Male · color fundus photograph · Topcon TRC-NW400 · non-mydriatic acquisition · disc-centered field · IOP 14 mmHg · FOV: 30 degrees · 2212x1661px · refraction: +2.25 -2 × 80°.
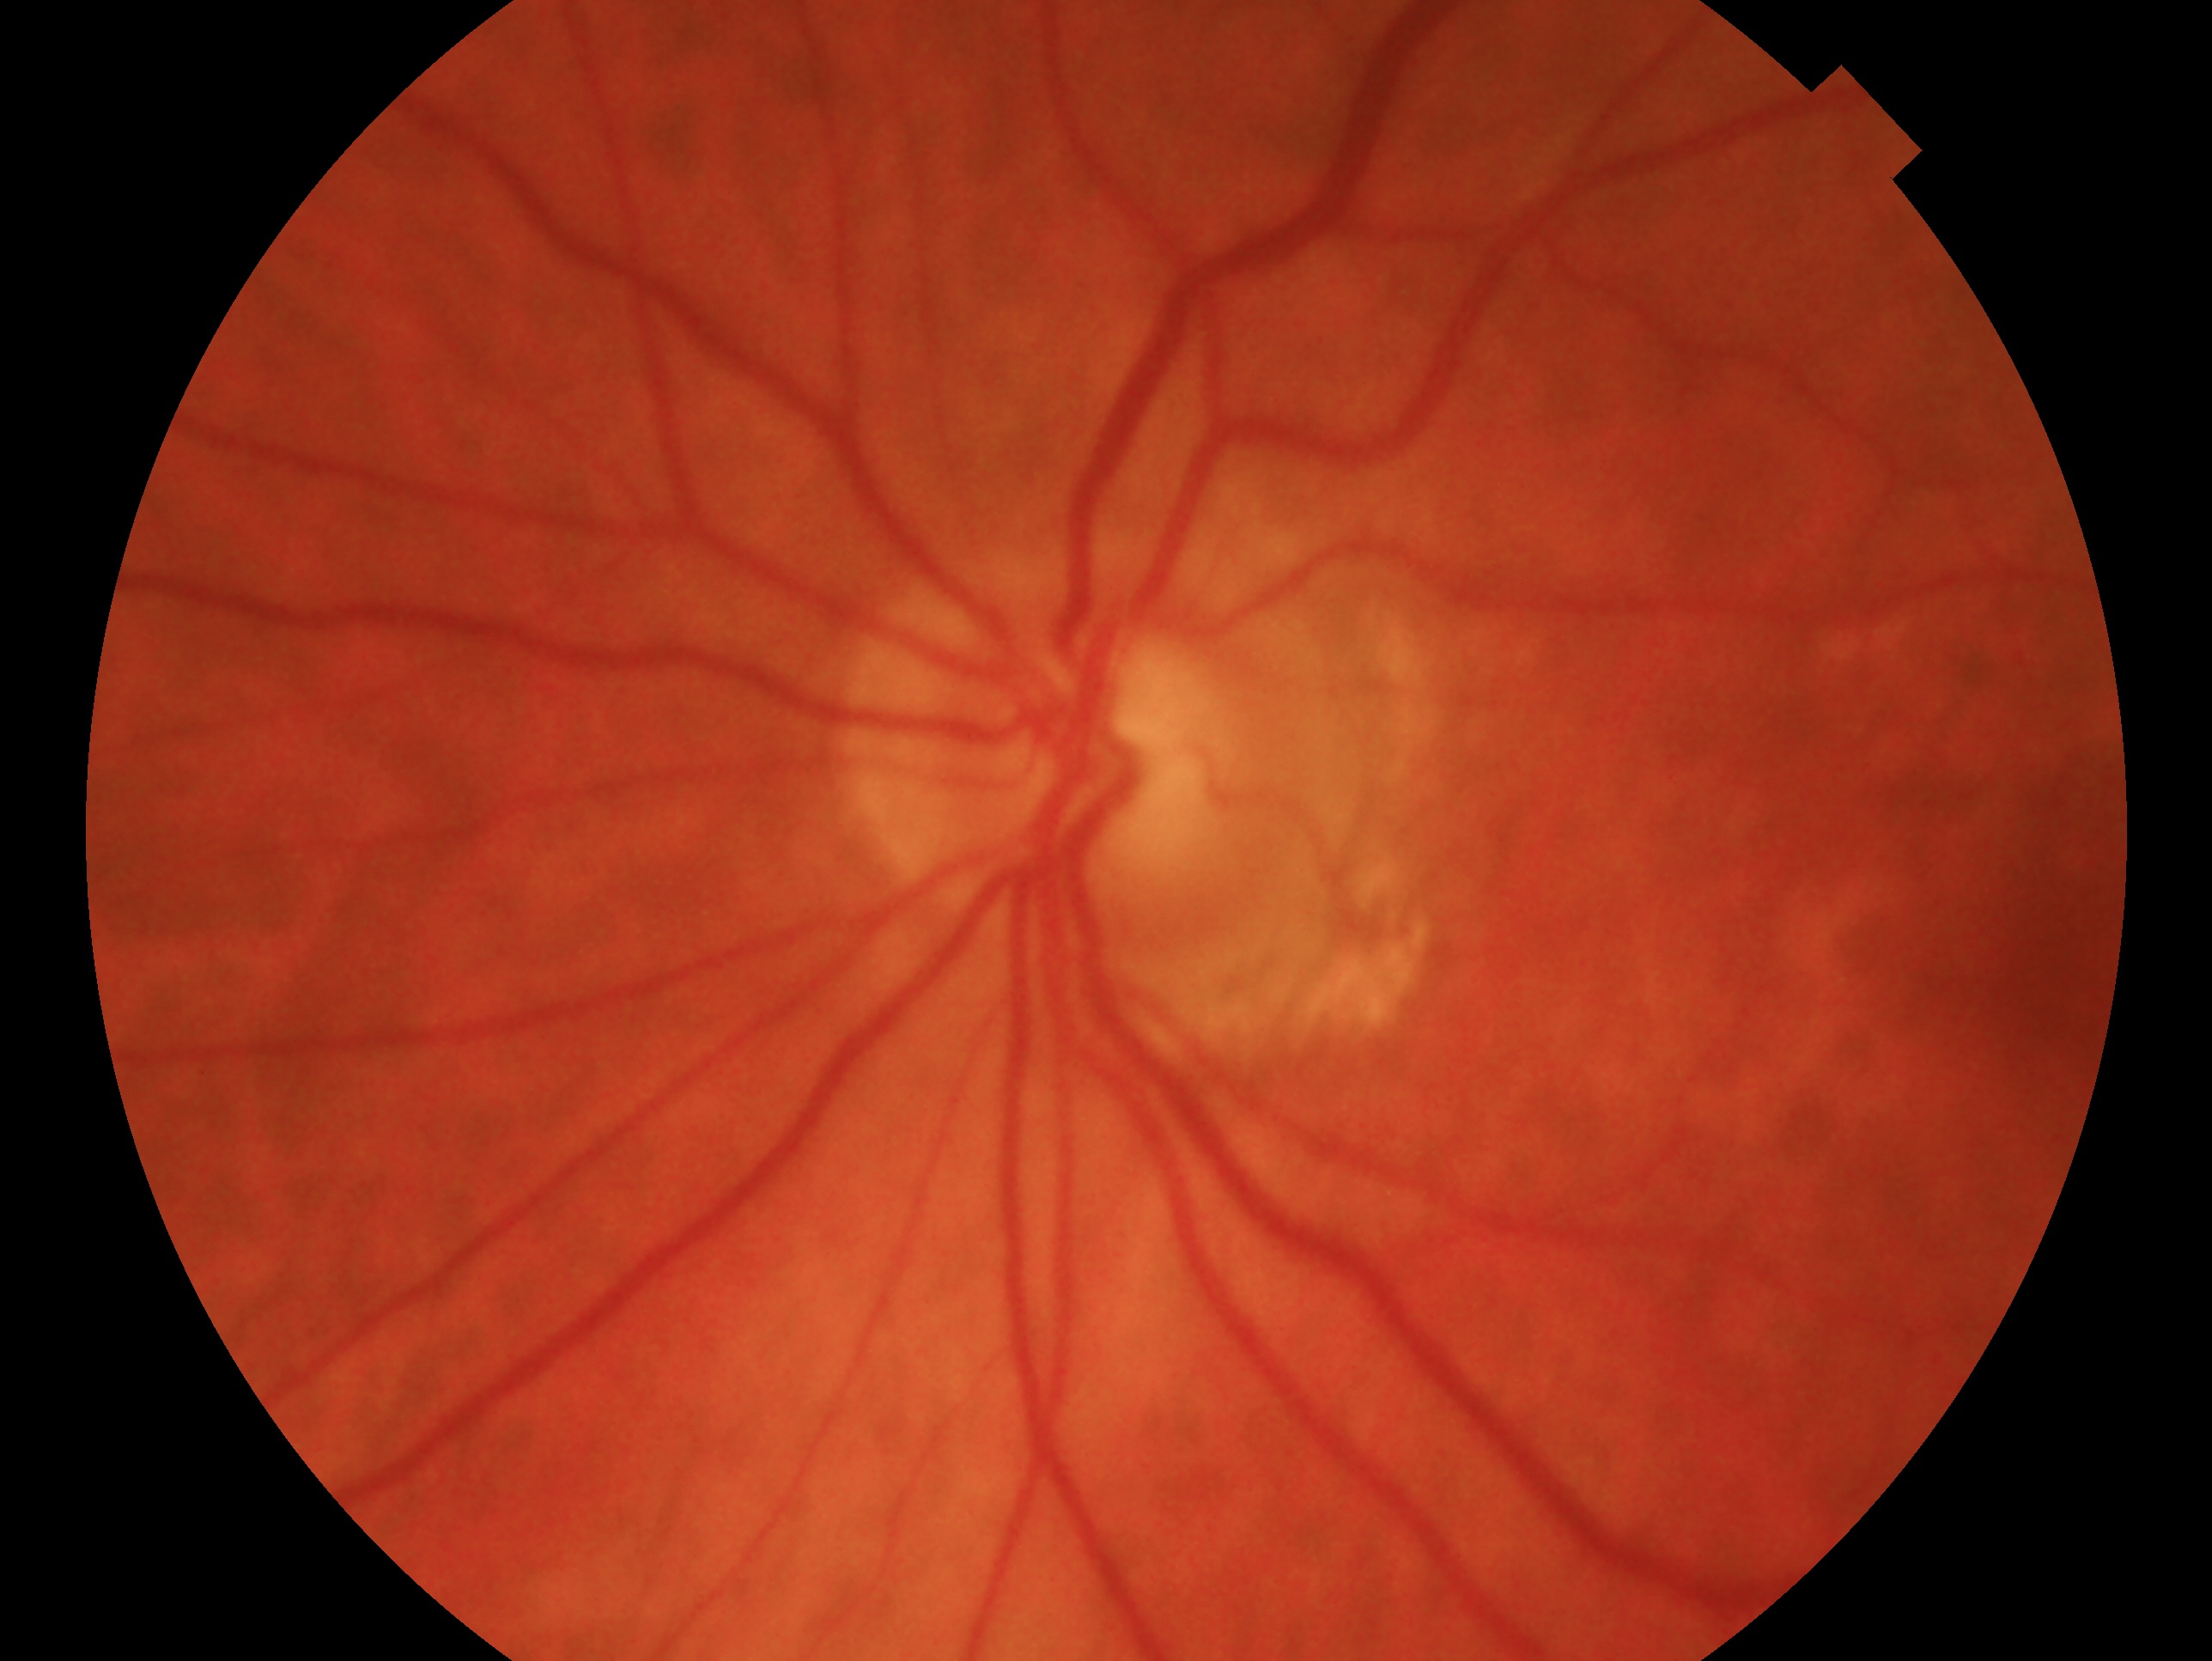 The image shows the OS. Assessment — negative for glaucoma.